Wide-field fundus photograph of an infant — 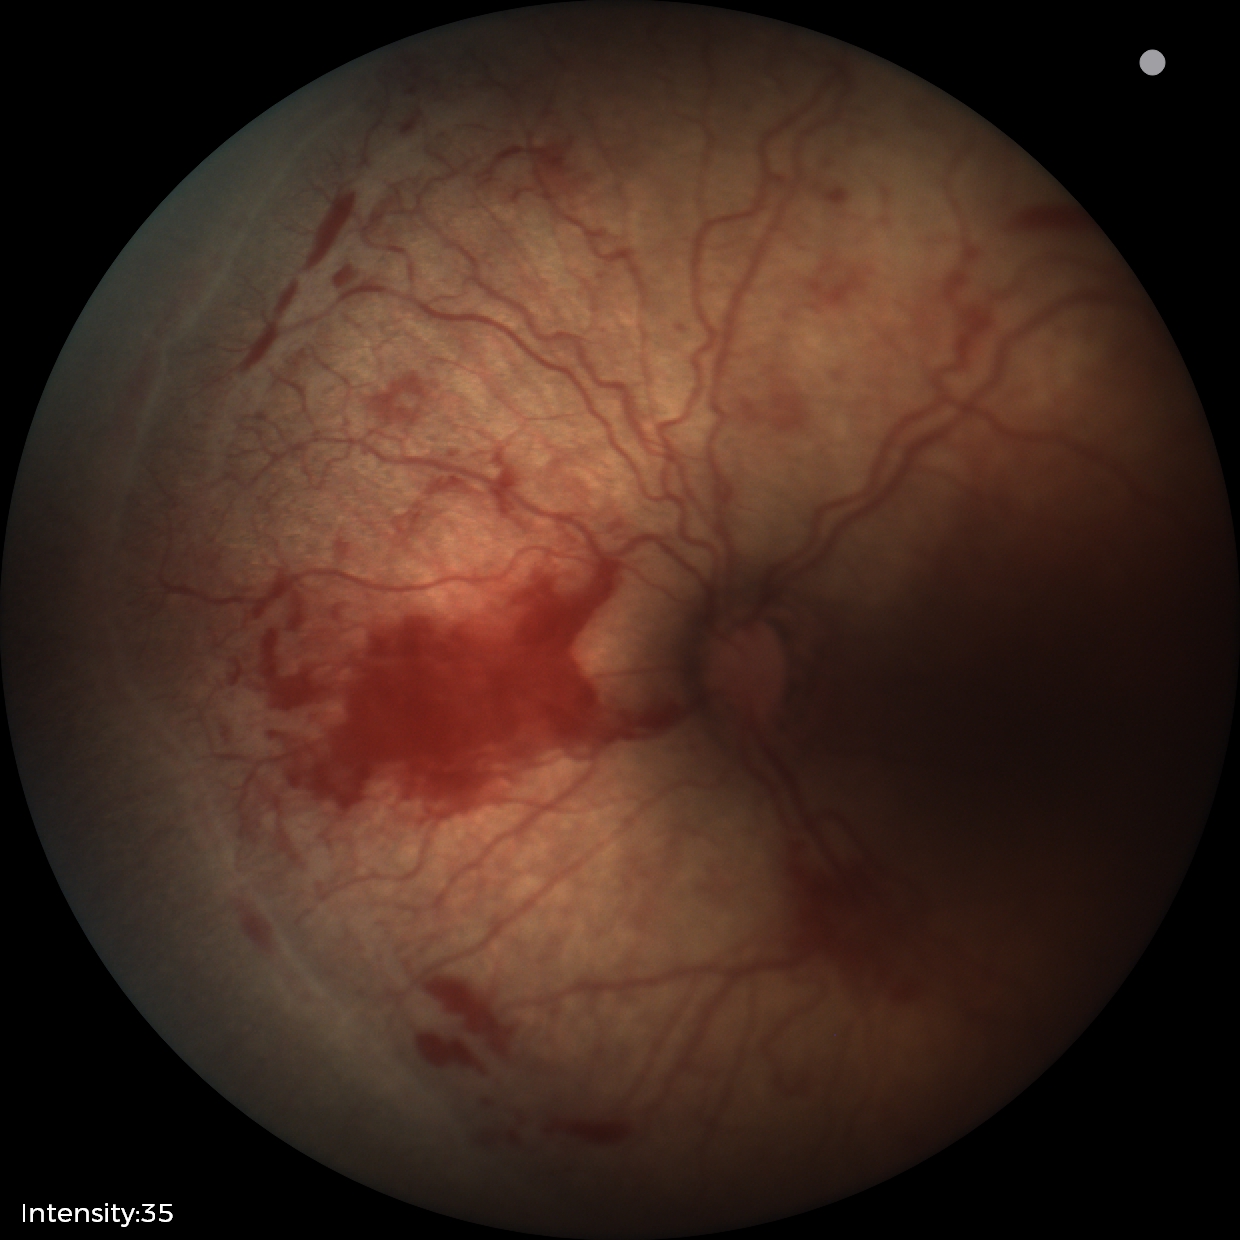 Finding: ROP stage 2, plus disease: present.